50-degree field of view
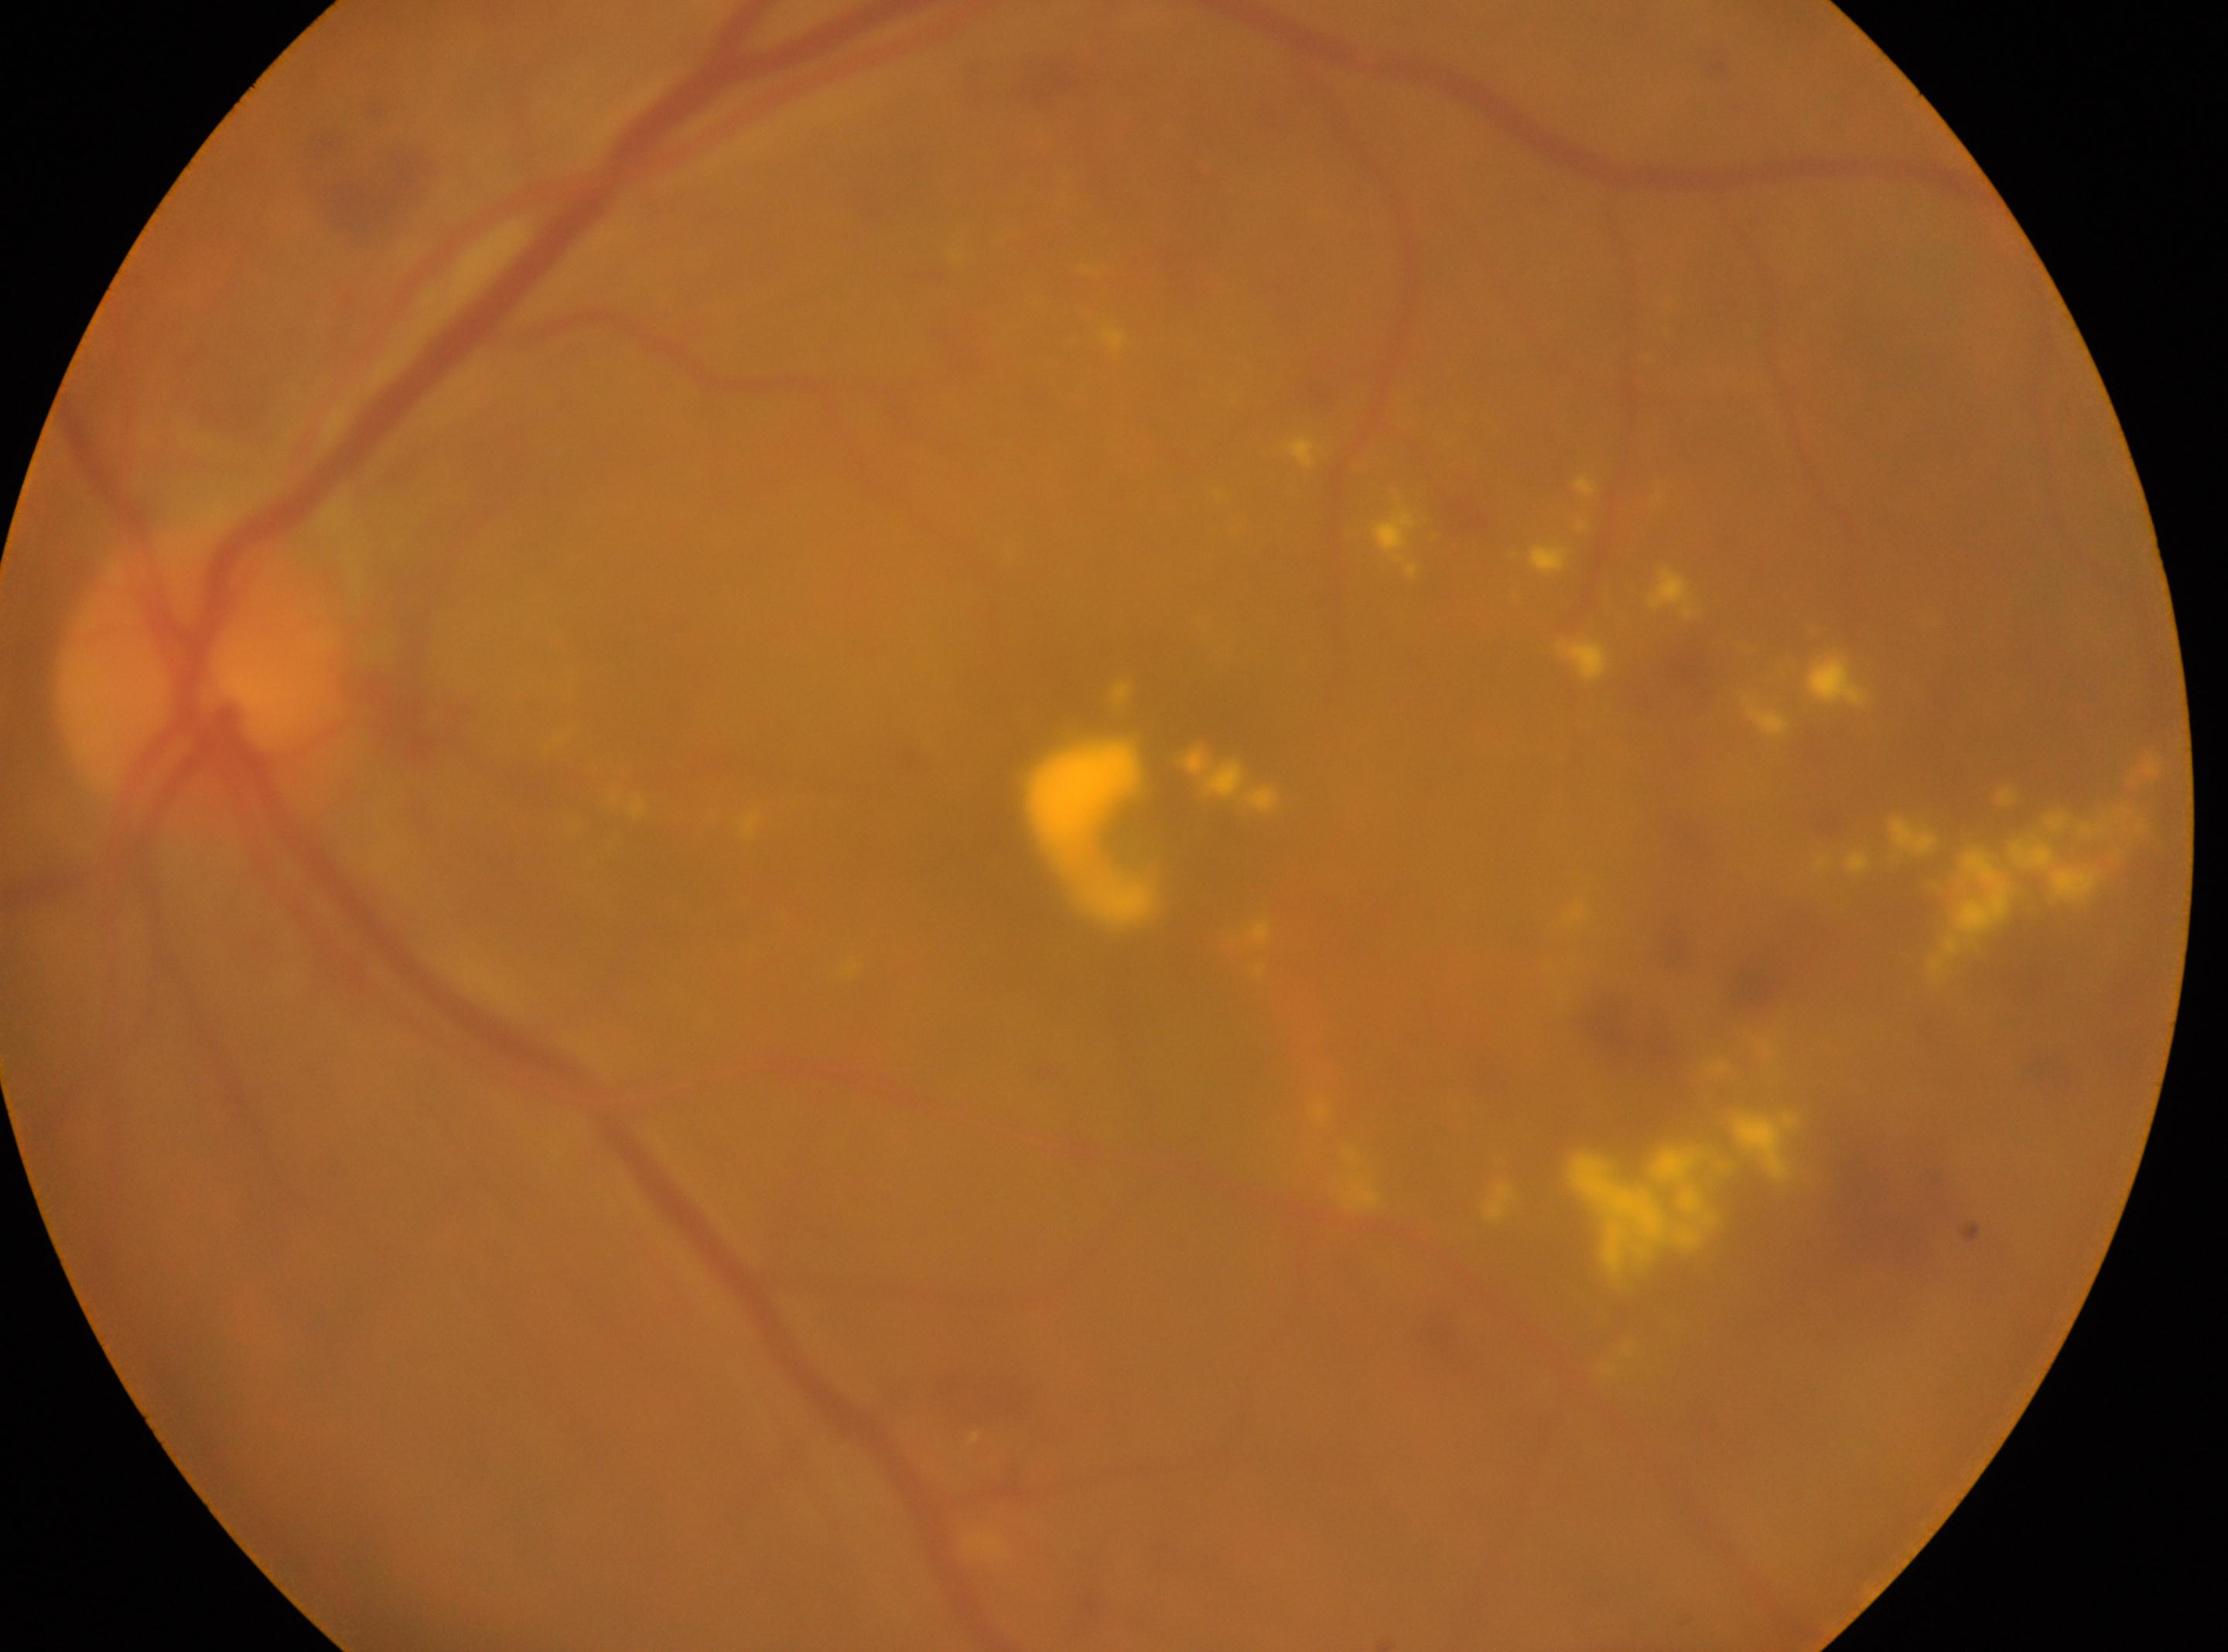
Imaged eye: the left eye. The macula center is at (x: 1148, y: 838). DR severity is moderate non-proliferative diabetic retinopathy (grade 2). The optic disc center is at (x: 204, y: 671).